45° FOV · fundus photo
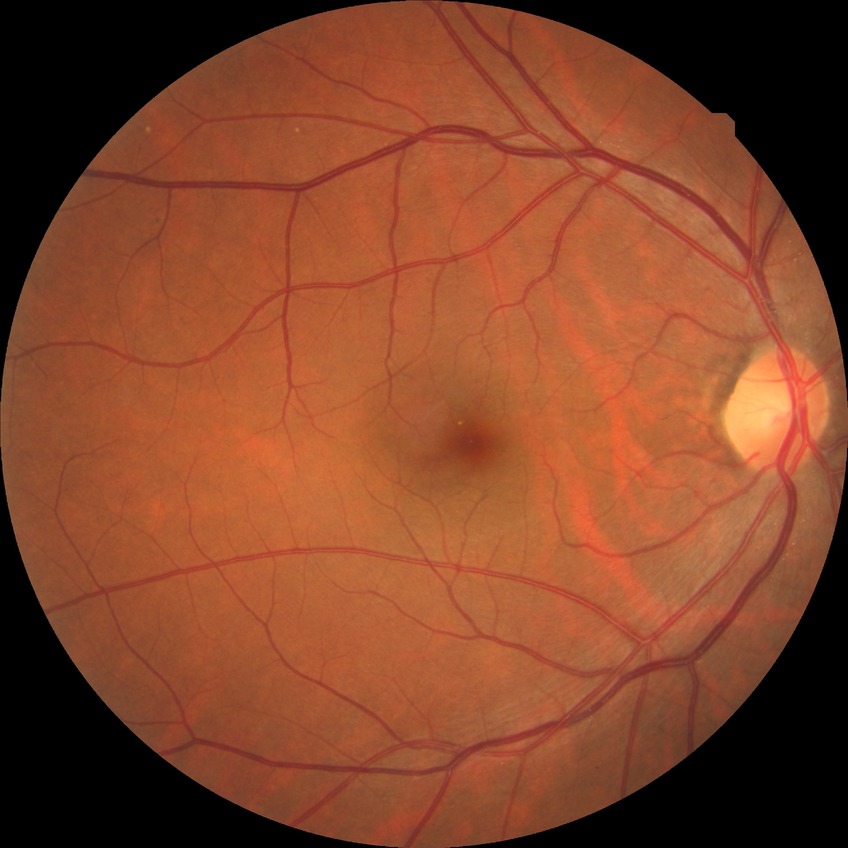

Retinopathy stage is no diabetic retinopathy.